Color fundus photograph; NIDEK AFC-230 — 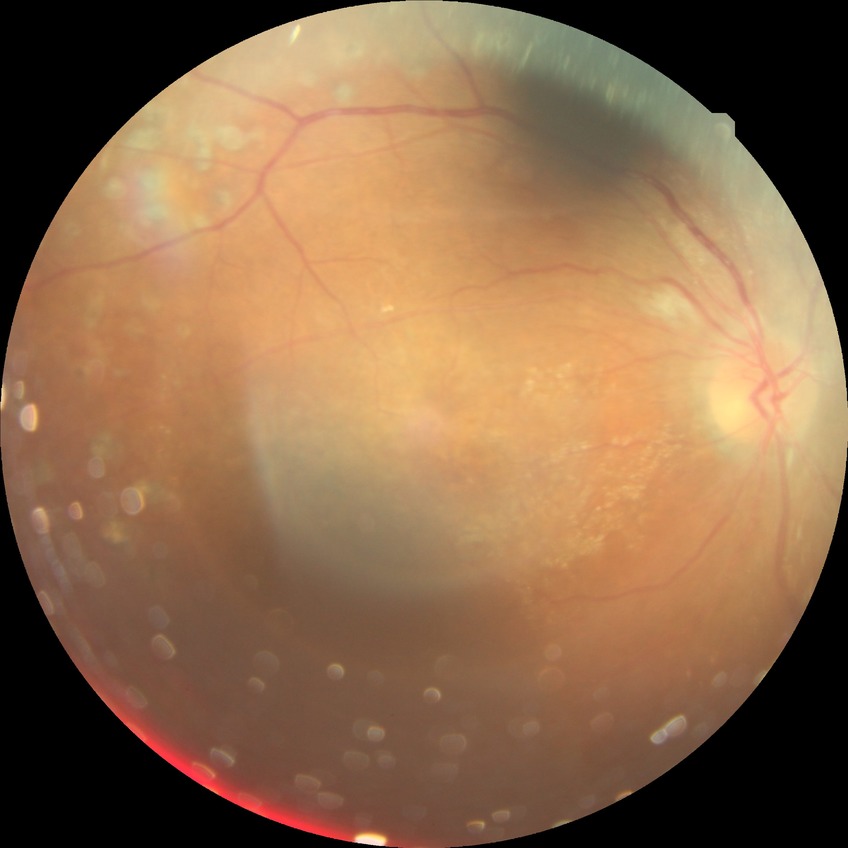

diabetic retinopathy (DR): proliferative diabetic retinopathy (PDR)